Acquired on the Phoenix ICON; Phoenix ICON wide-field infant fundus image; 1240x1240 — 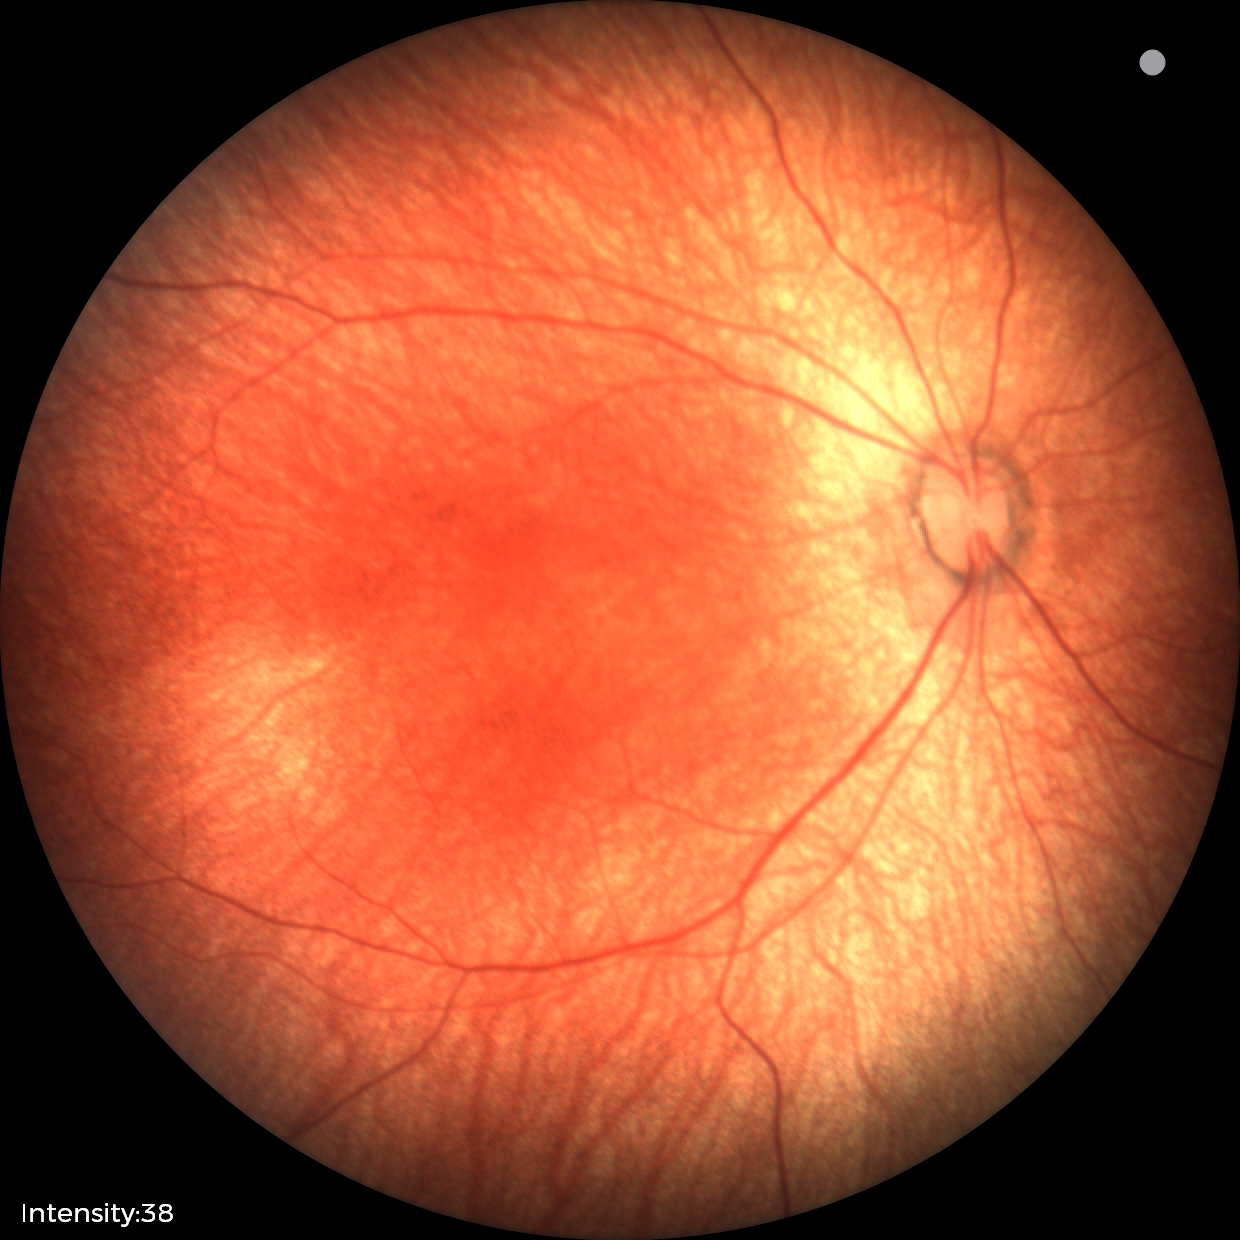

Screening examination diagnosed as physiological.